Image size 1659x2212 — 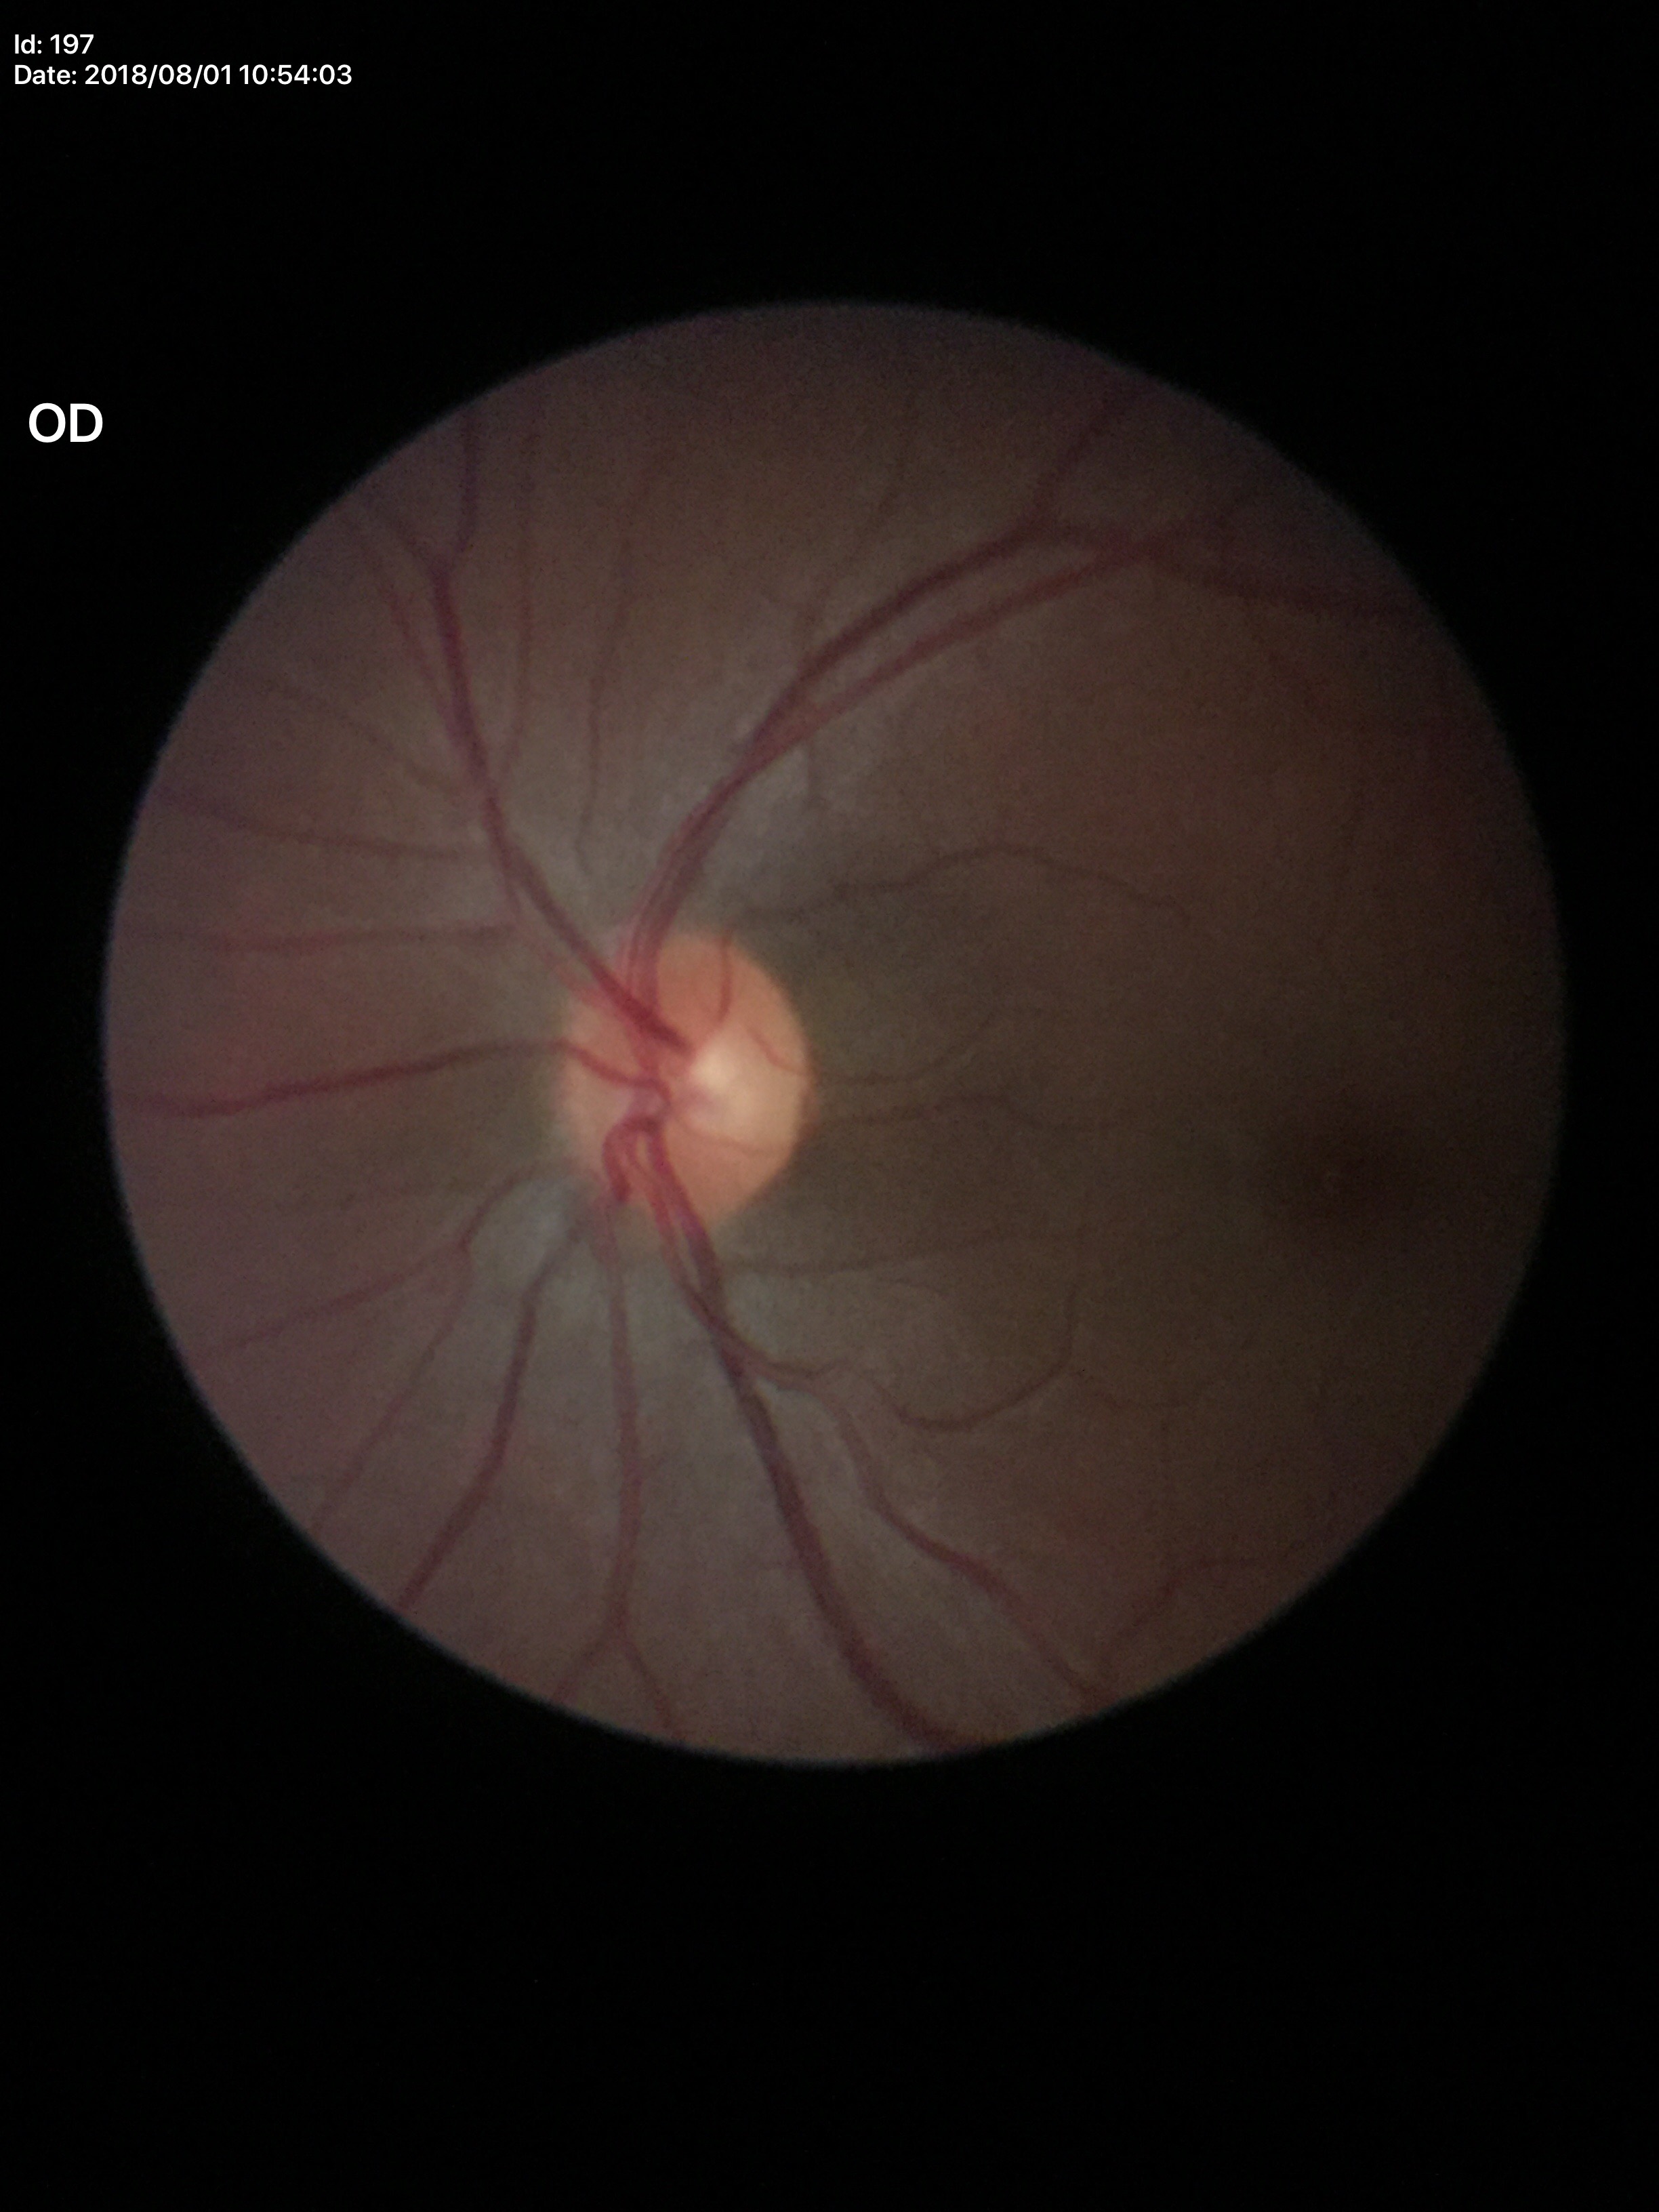
• Glaucoma screening · no suspicious findings
• vertical CDR (VCDR) · 0.47